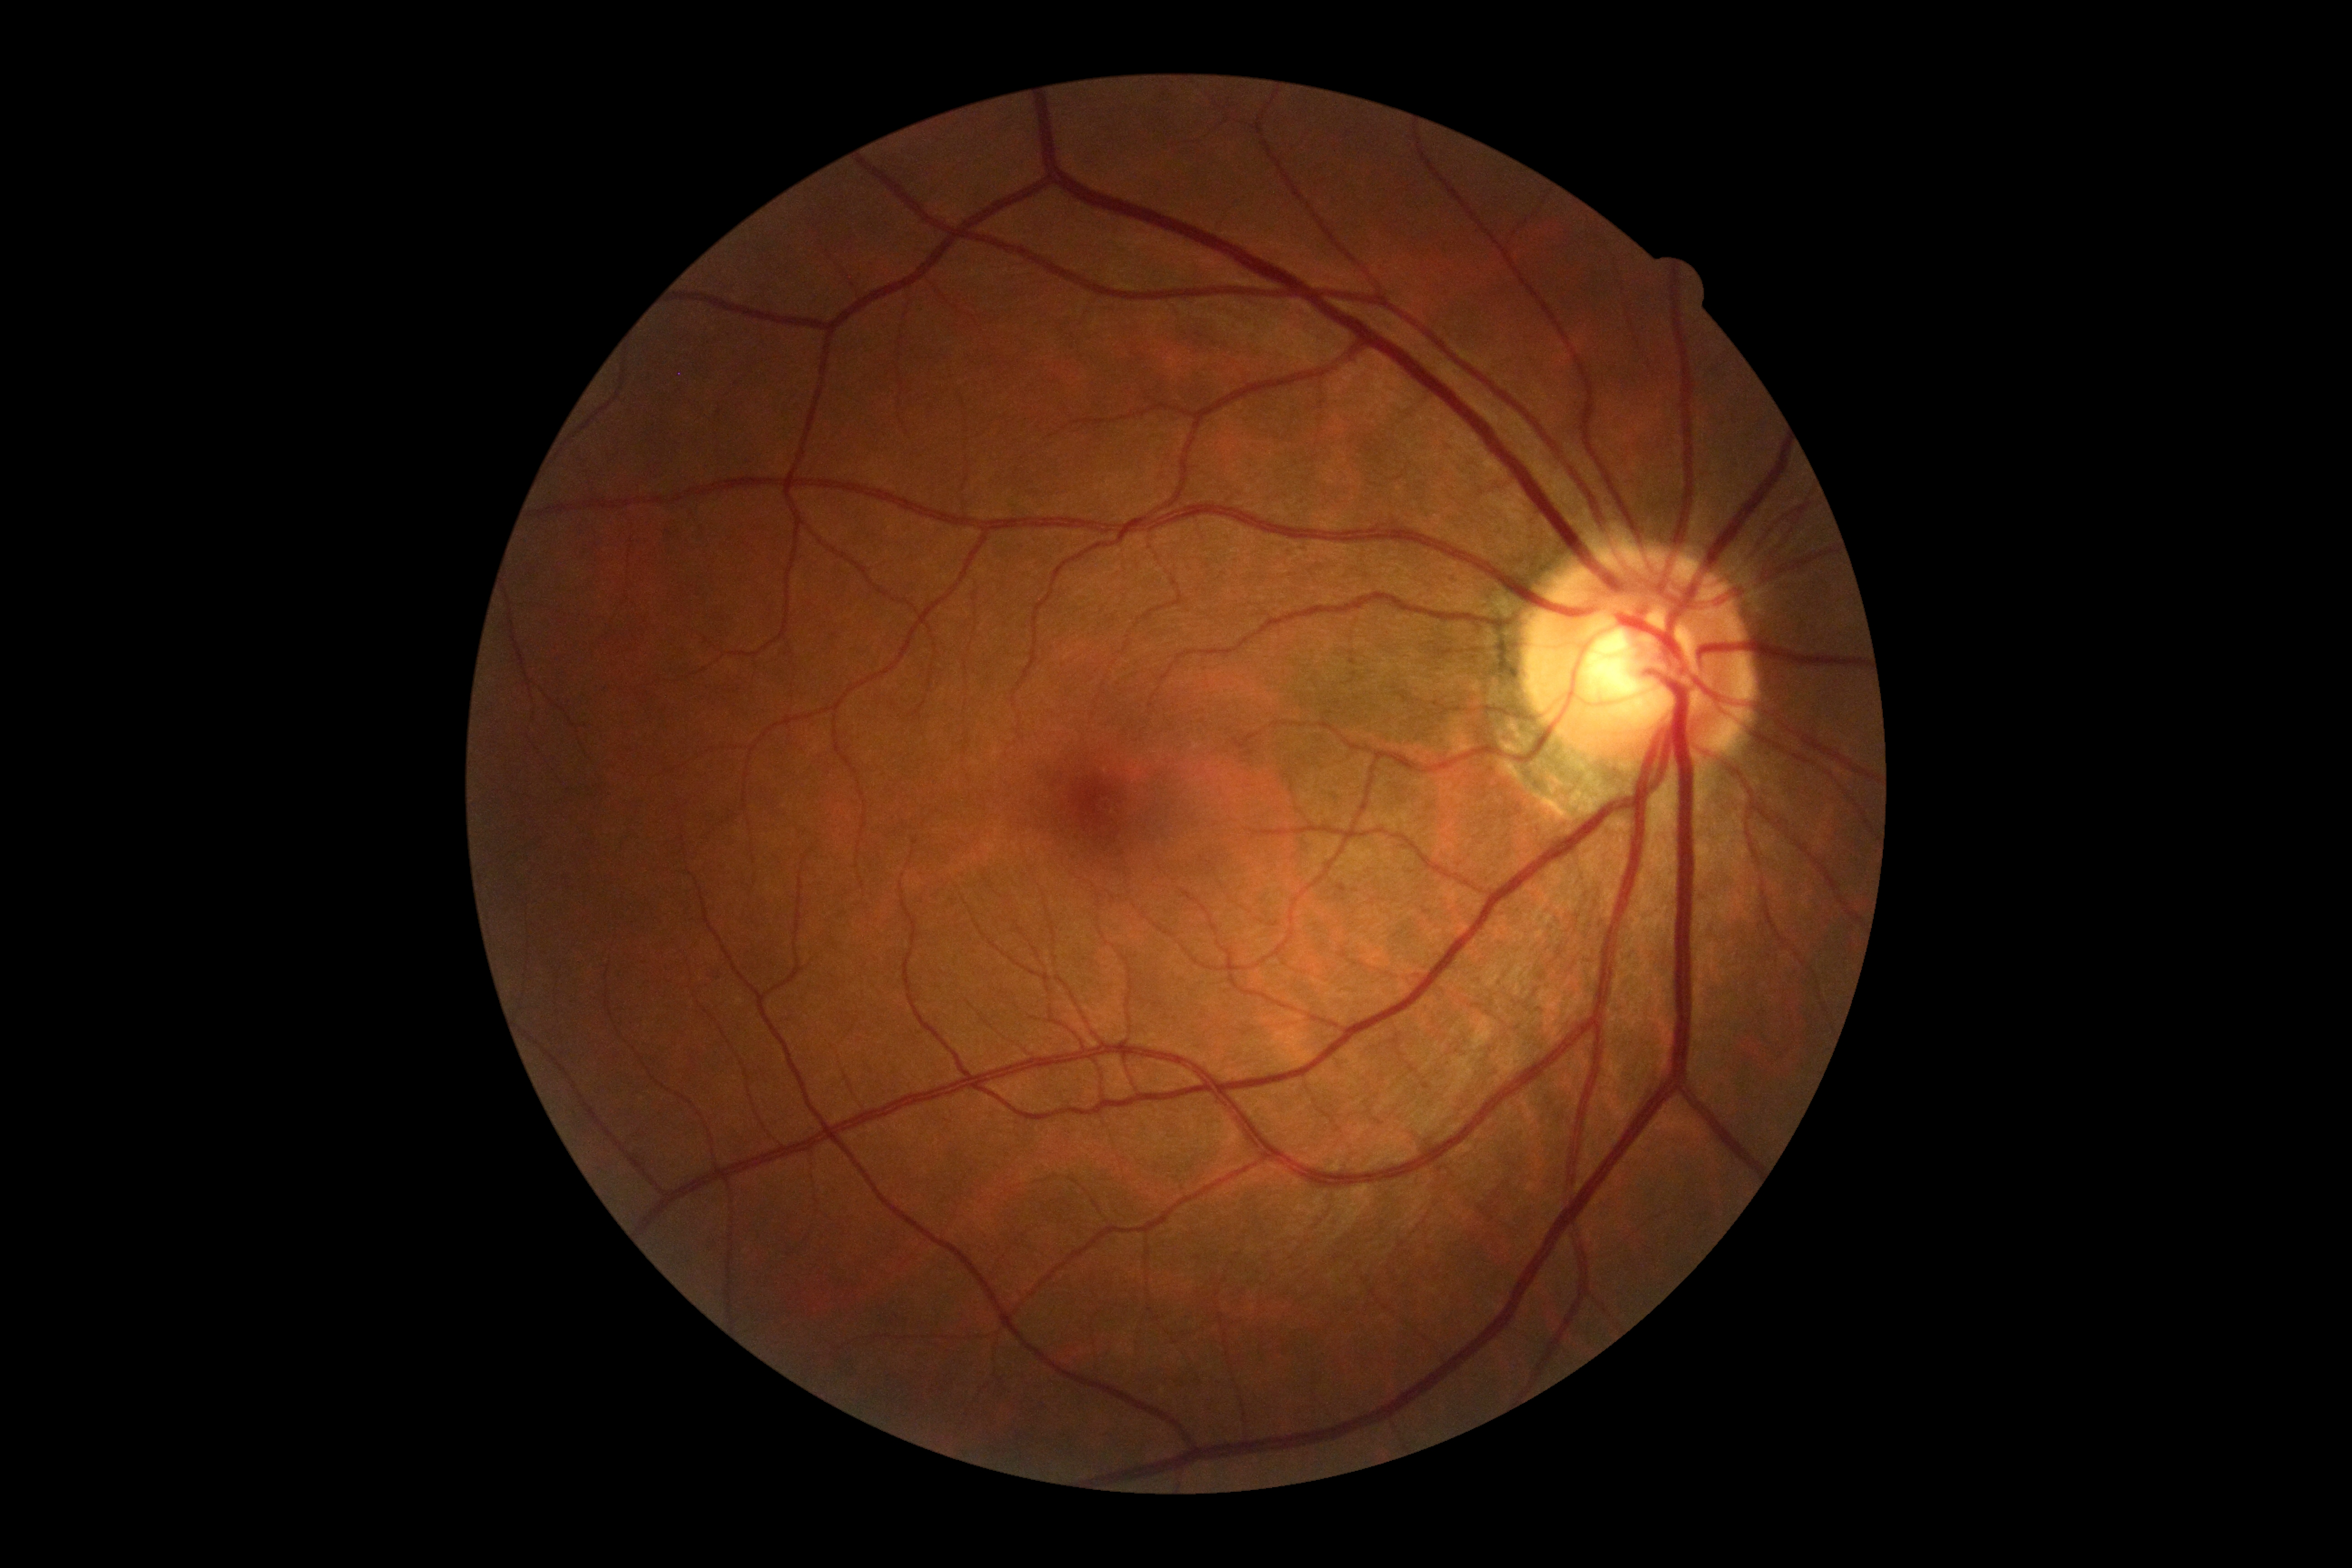

Diabetic retinopathy grade: 0 — no visible signs of diabetic retinopathy.